Fundus photograph cropped around the optic nerve head — 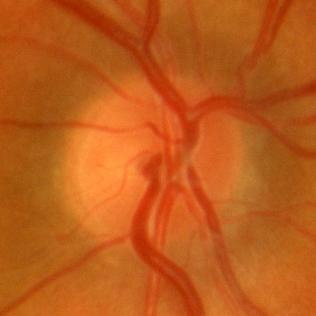
No glaucomatous changes.